Captured on a Nidek AFC-330 fundus camera; 240x240 — 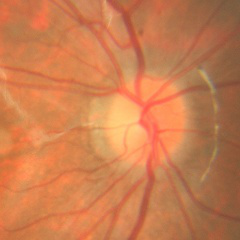 Q: What is the glaucoma diagnosis?
A: No glaucoma.